Wide-field contact fundus photograph of an infant: 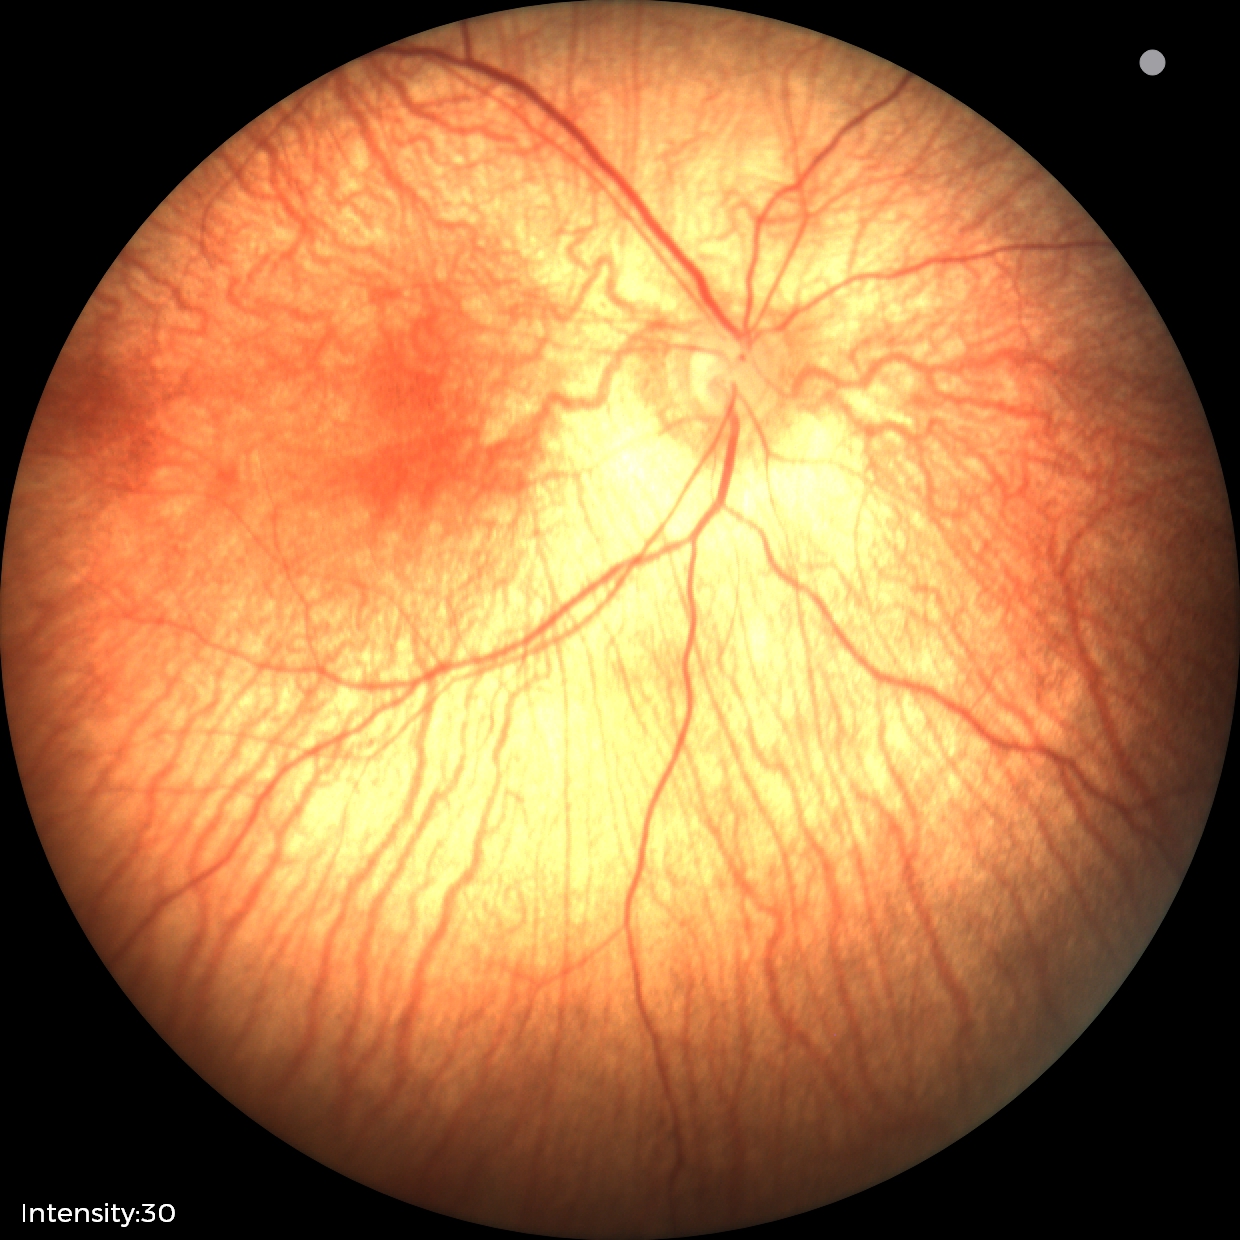
Screening: normal retinal appearance.